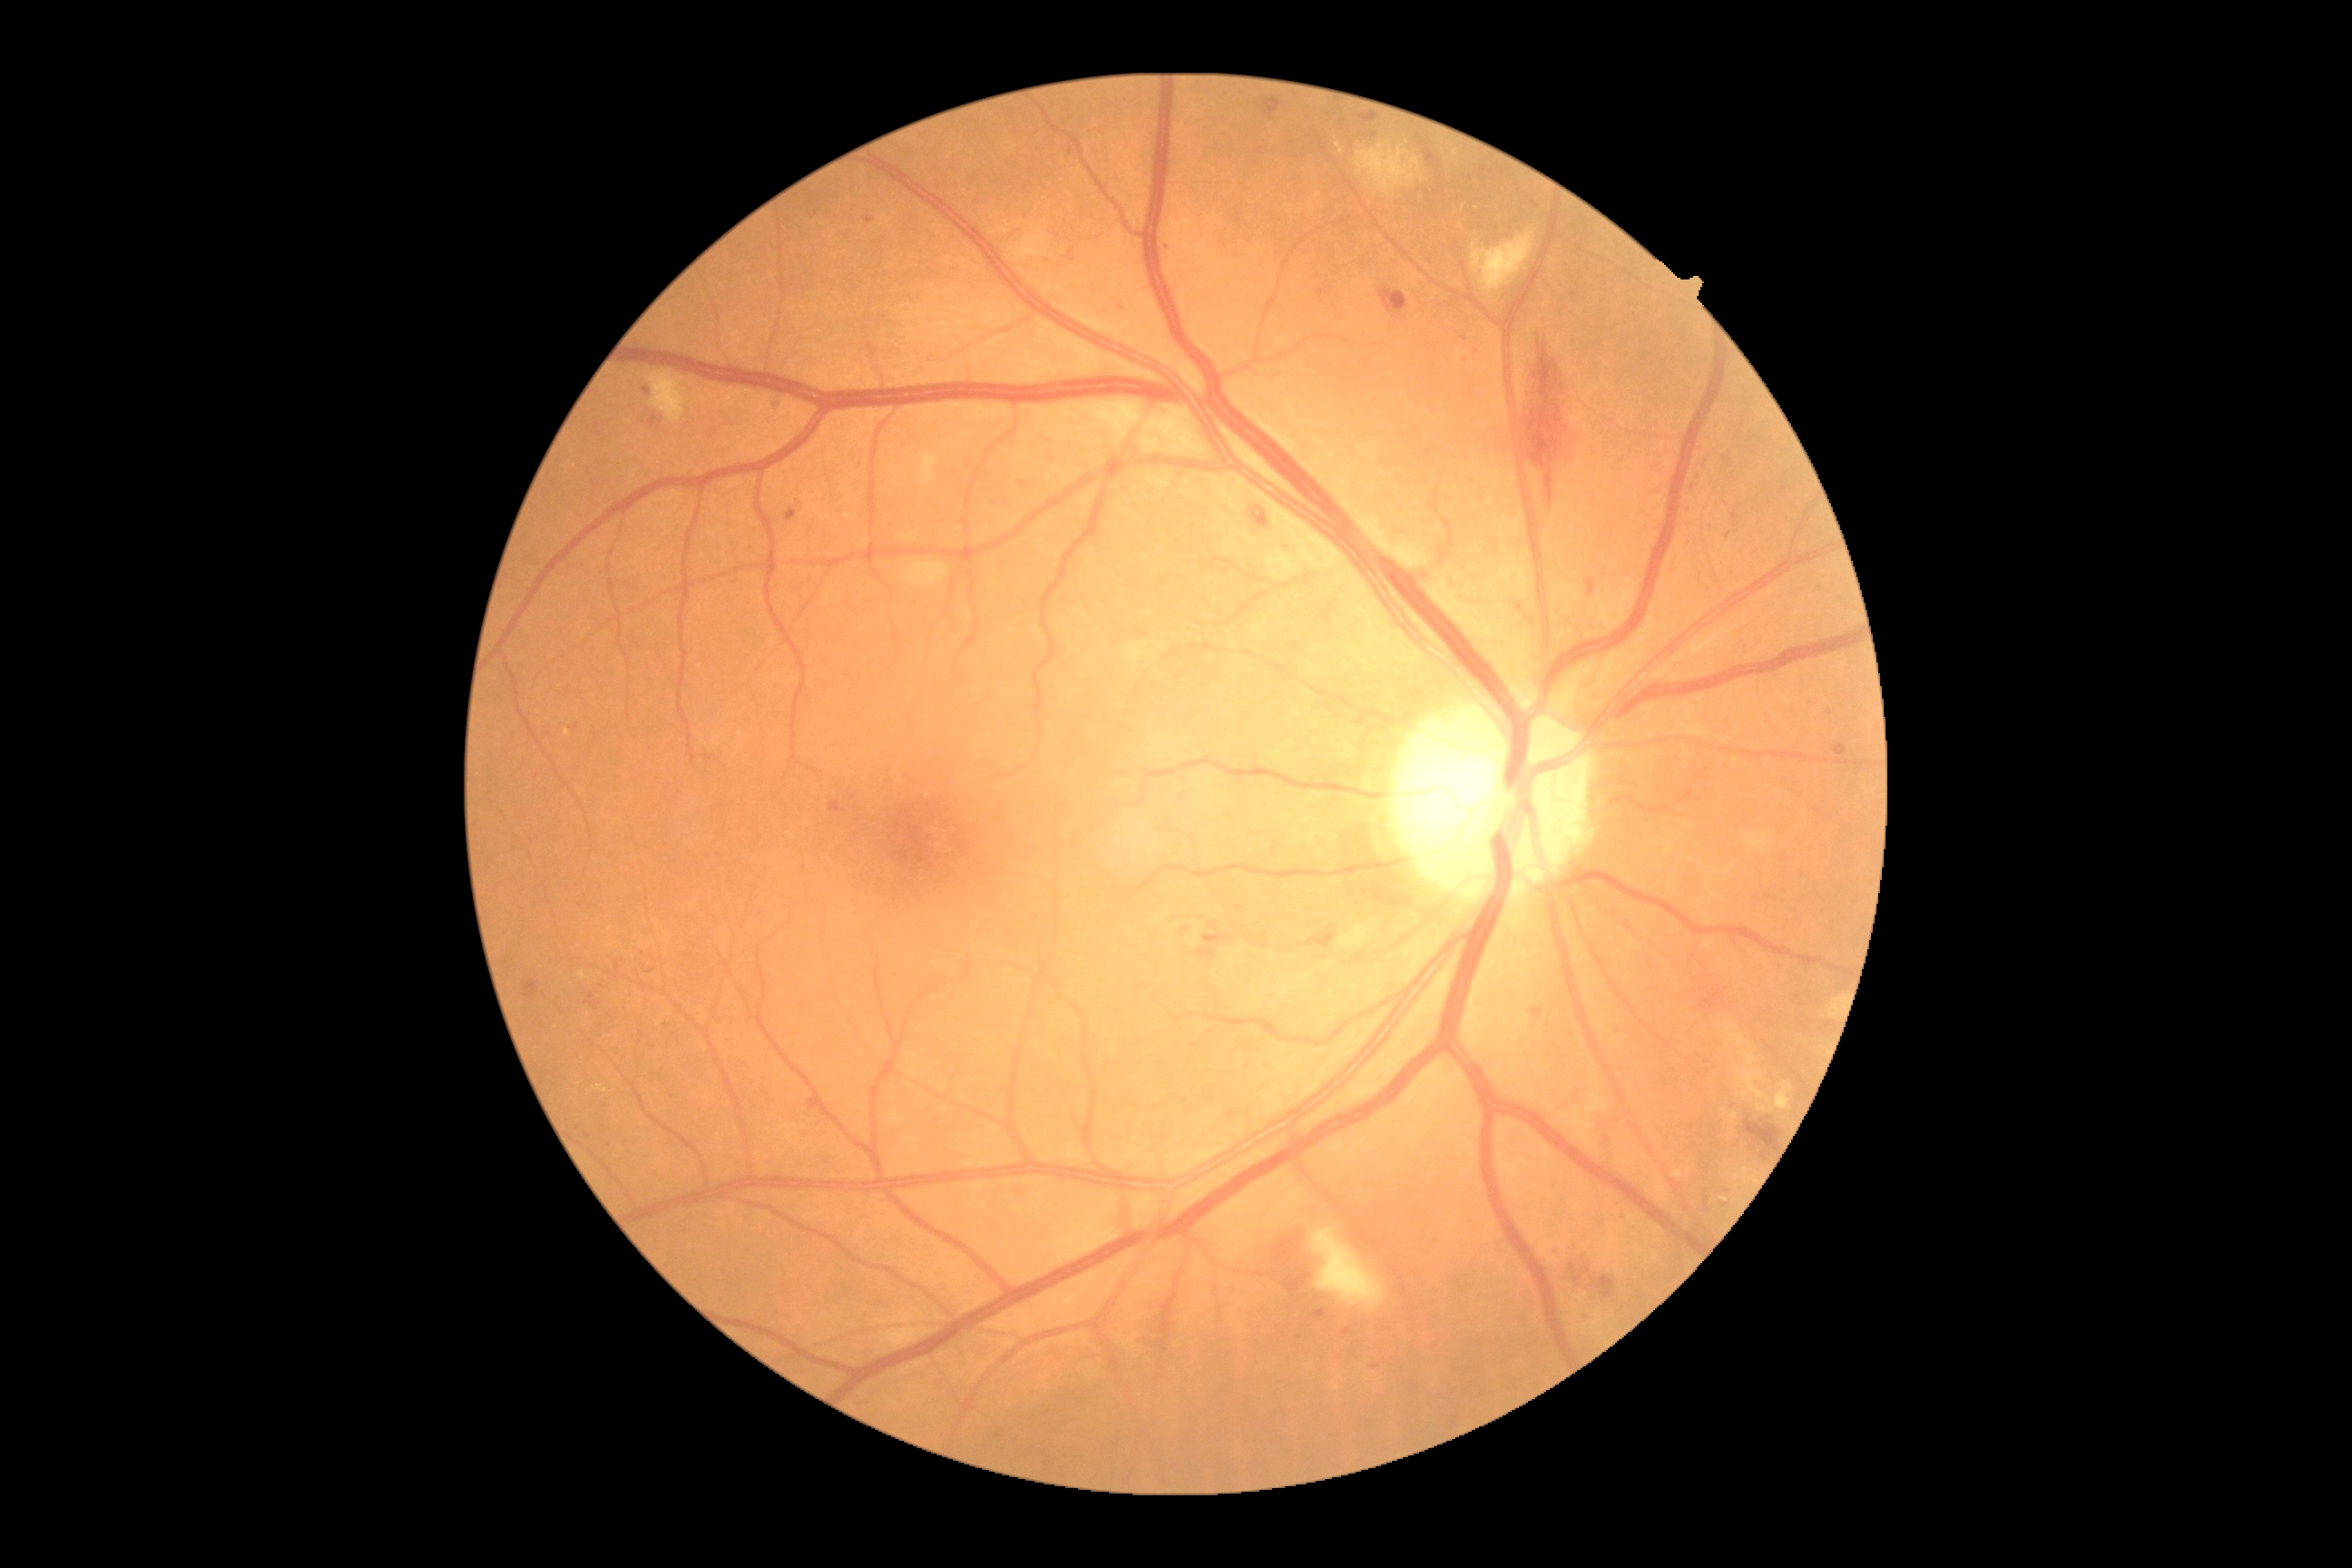
DR grade: 2 (moderate NPDR)
Representative lesions:
MAs (subset): [1465,338,1471,346] | [830,801,847,814] | [1618,1213,1627,1220] | [585,992,602,1008] | [1689,485,1696,496] | [1732,513,1740,525] | [1315,1309,1326,1320] | [647,968,656,974]
Additional small MAs near Point(619, 966) | Point(1727, 1192) | Point(1463, 354) | Point(1705, 463) | Point(1302, 1336) | Point(1006, 504) | Point(609, 1146)
HEs: [1571,1255,1625,1298] | [1300,934,1337,950] | [1380,288,1407,313] | [1260,99,1282,117] | [1277,1233,1302,1266] | [1587,580,1598,596] | [1197,934,1233,961] | [1736,1102,1785,1153] | [1251,509,1269,529] | [1288,1260,1313,1295] | [1426,150,1440,166] | [1516,337,1576,504] | [1360,115,1378,122]
EXs (subset): [1727,1113,1738,1122] | [1721,1197,1729,1202] | [1776,1083,1792,1112] | [1736,1066,1769,1101] | [594,1086,602,1090] | [580,970,587,981] | [1747,1052,1756,1066] | [1674,1171,1683,1179] | [1725,1023,1754,1052]
Additional small EXs near Point(1477, 208) | Point(1338, 145) | Point(1463, 208) | Point(1455, 152) | Point(1746, 1172) | Point(606, 1090) | Point(567, 732)
SEs: [1473,231,1534,293] | [903,562,950,587] | [912,451,939,484] | [1357,146,1420,197] | [647,373,687,424] | [1311,1226,1386,1309]